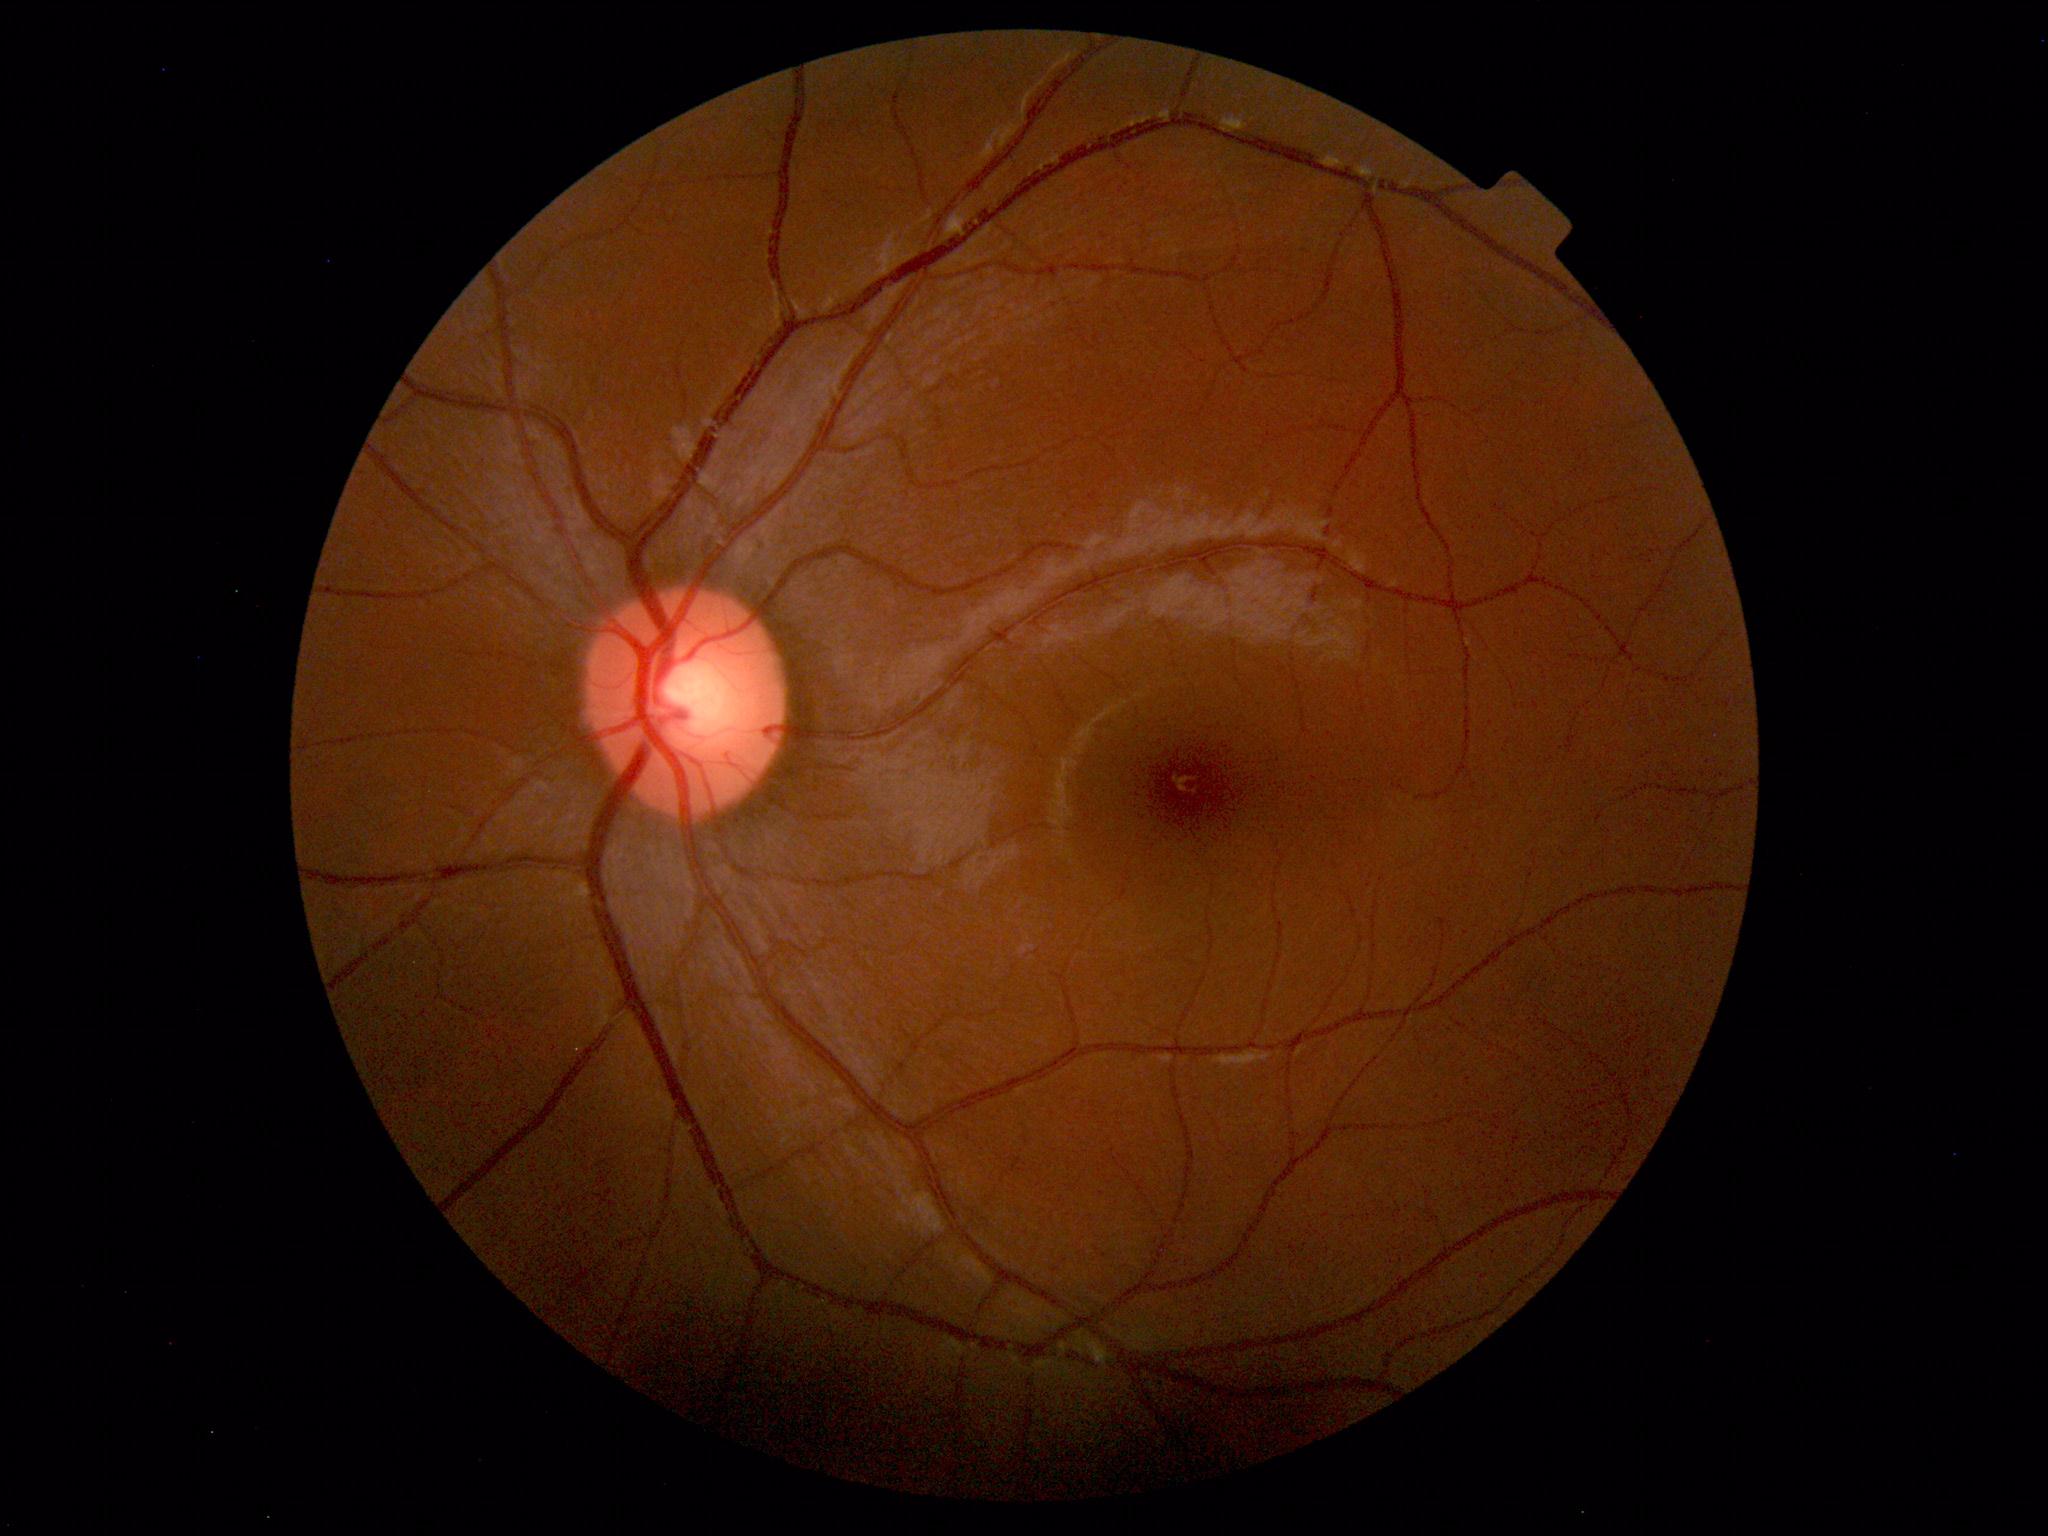
The fundus appears normal with no pathological findings.